Without pupil dilation
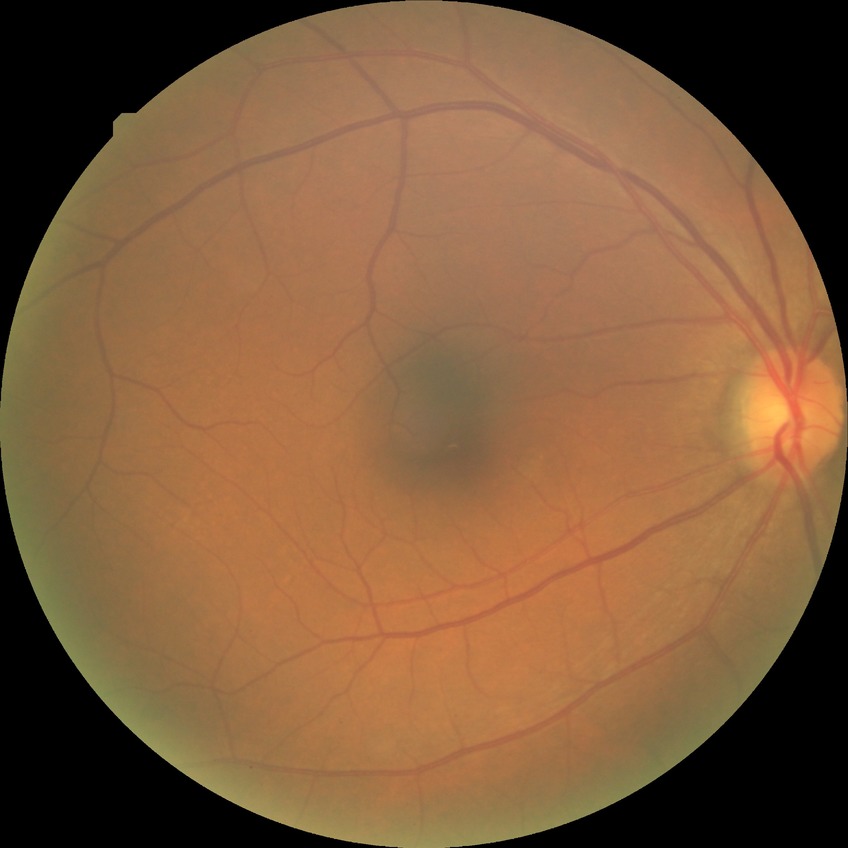
Retinopathy stage: no diabetic retinopathy.